CFP, modified Davis classification, 45° FOV — 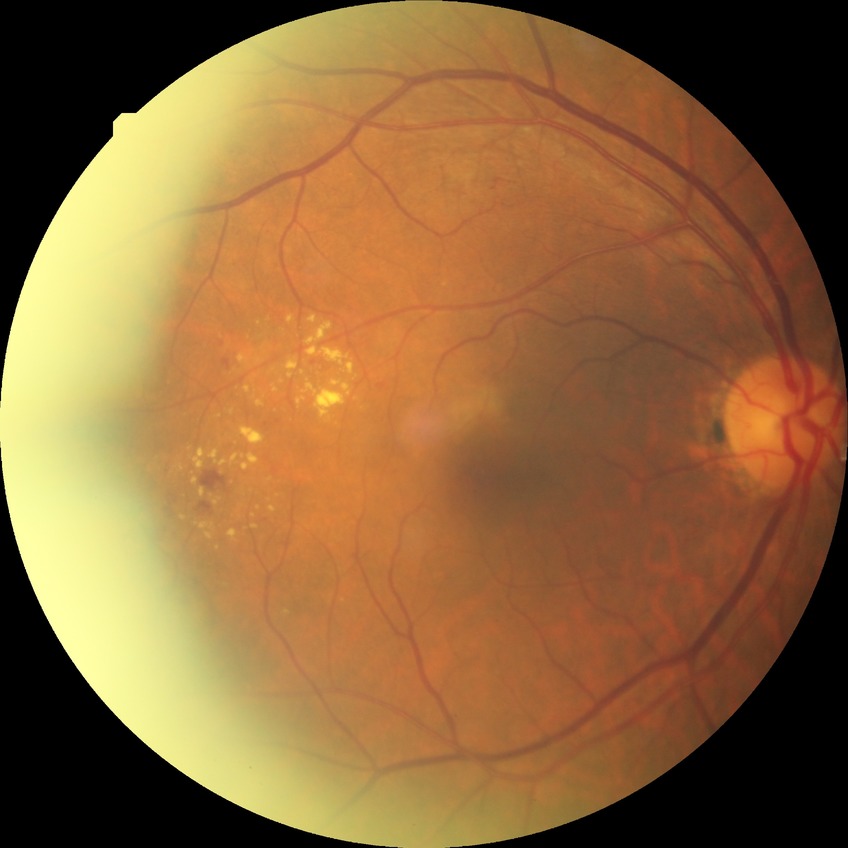
Diabetic retinopathy (DR) is simple diabetic retinopathy (SDR).